Modified Davis grading.
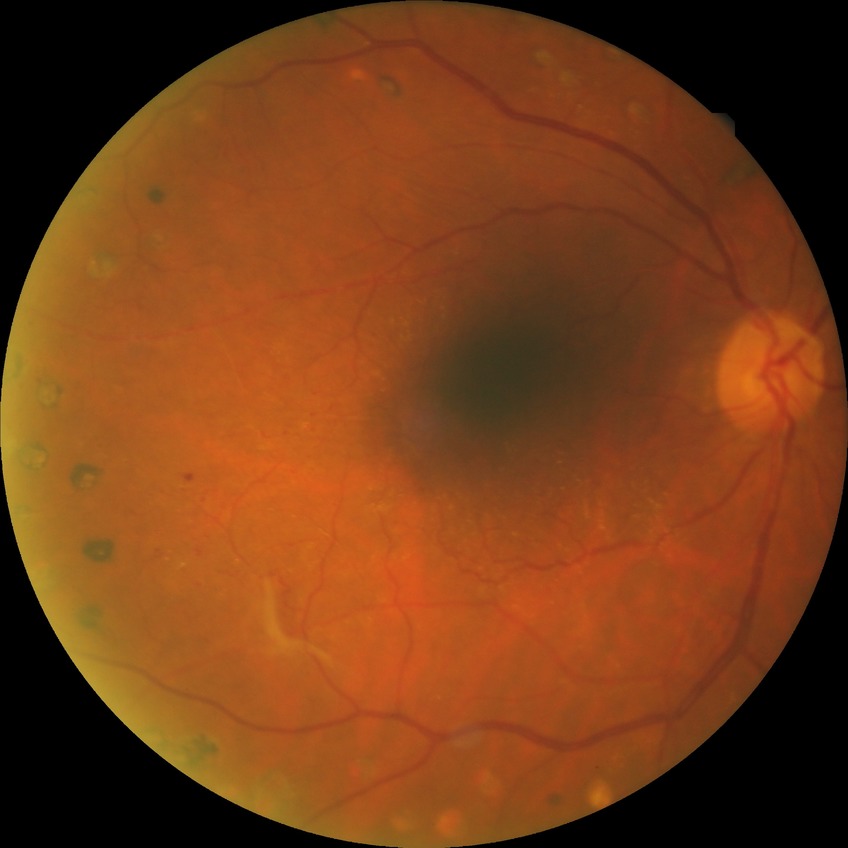

modified Davis classification: proliferative diabetic retinopathy.